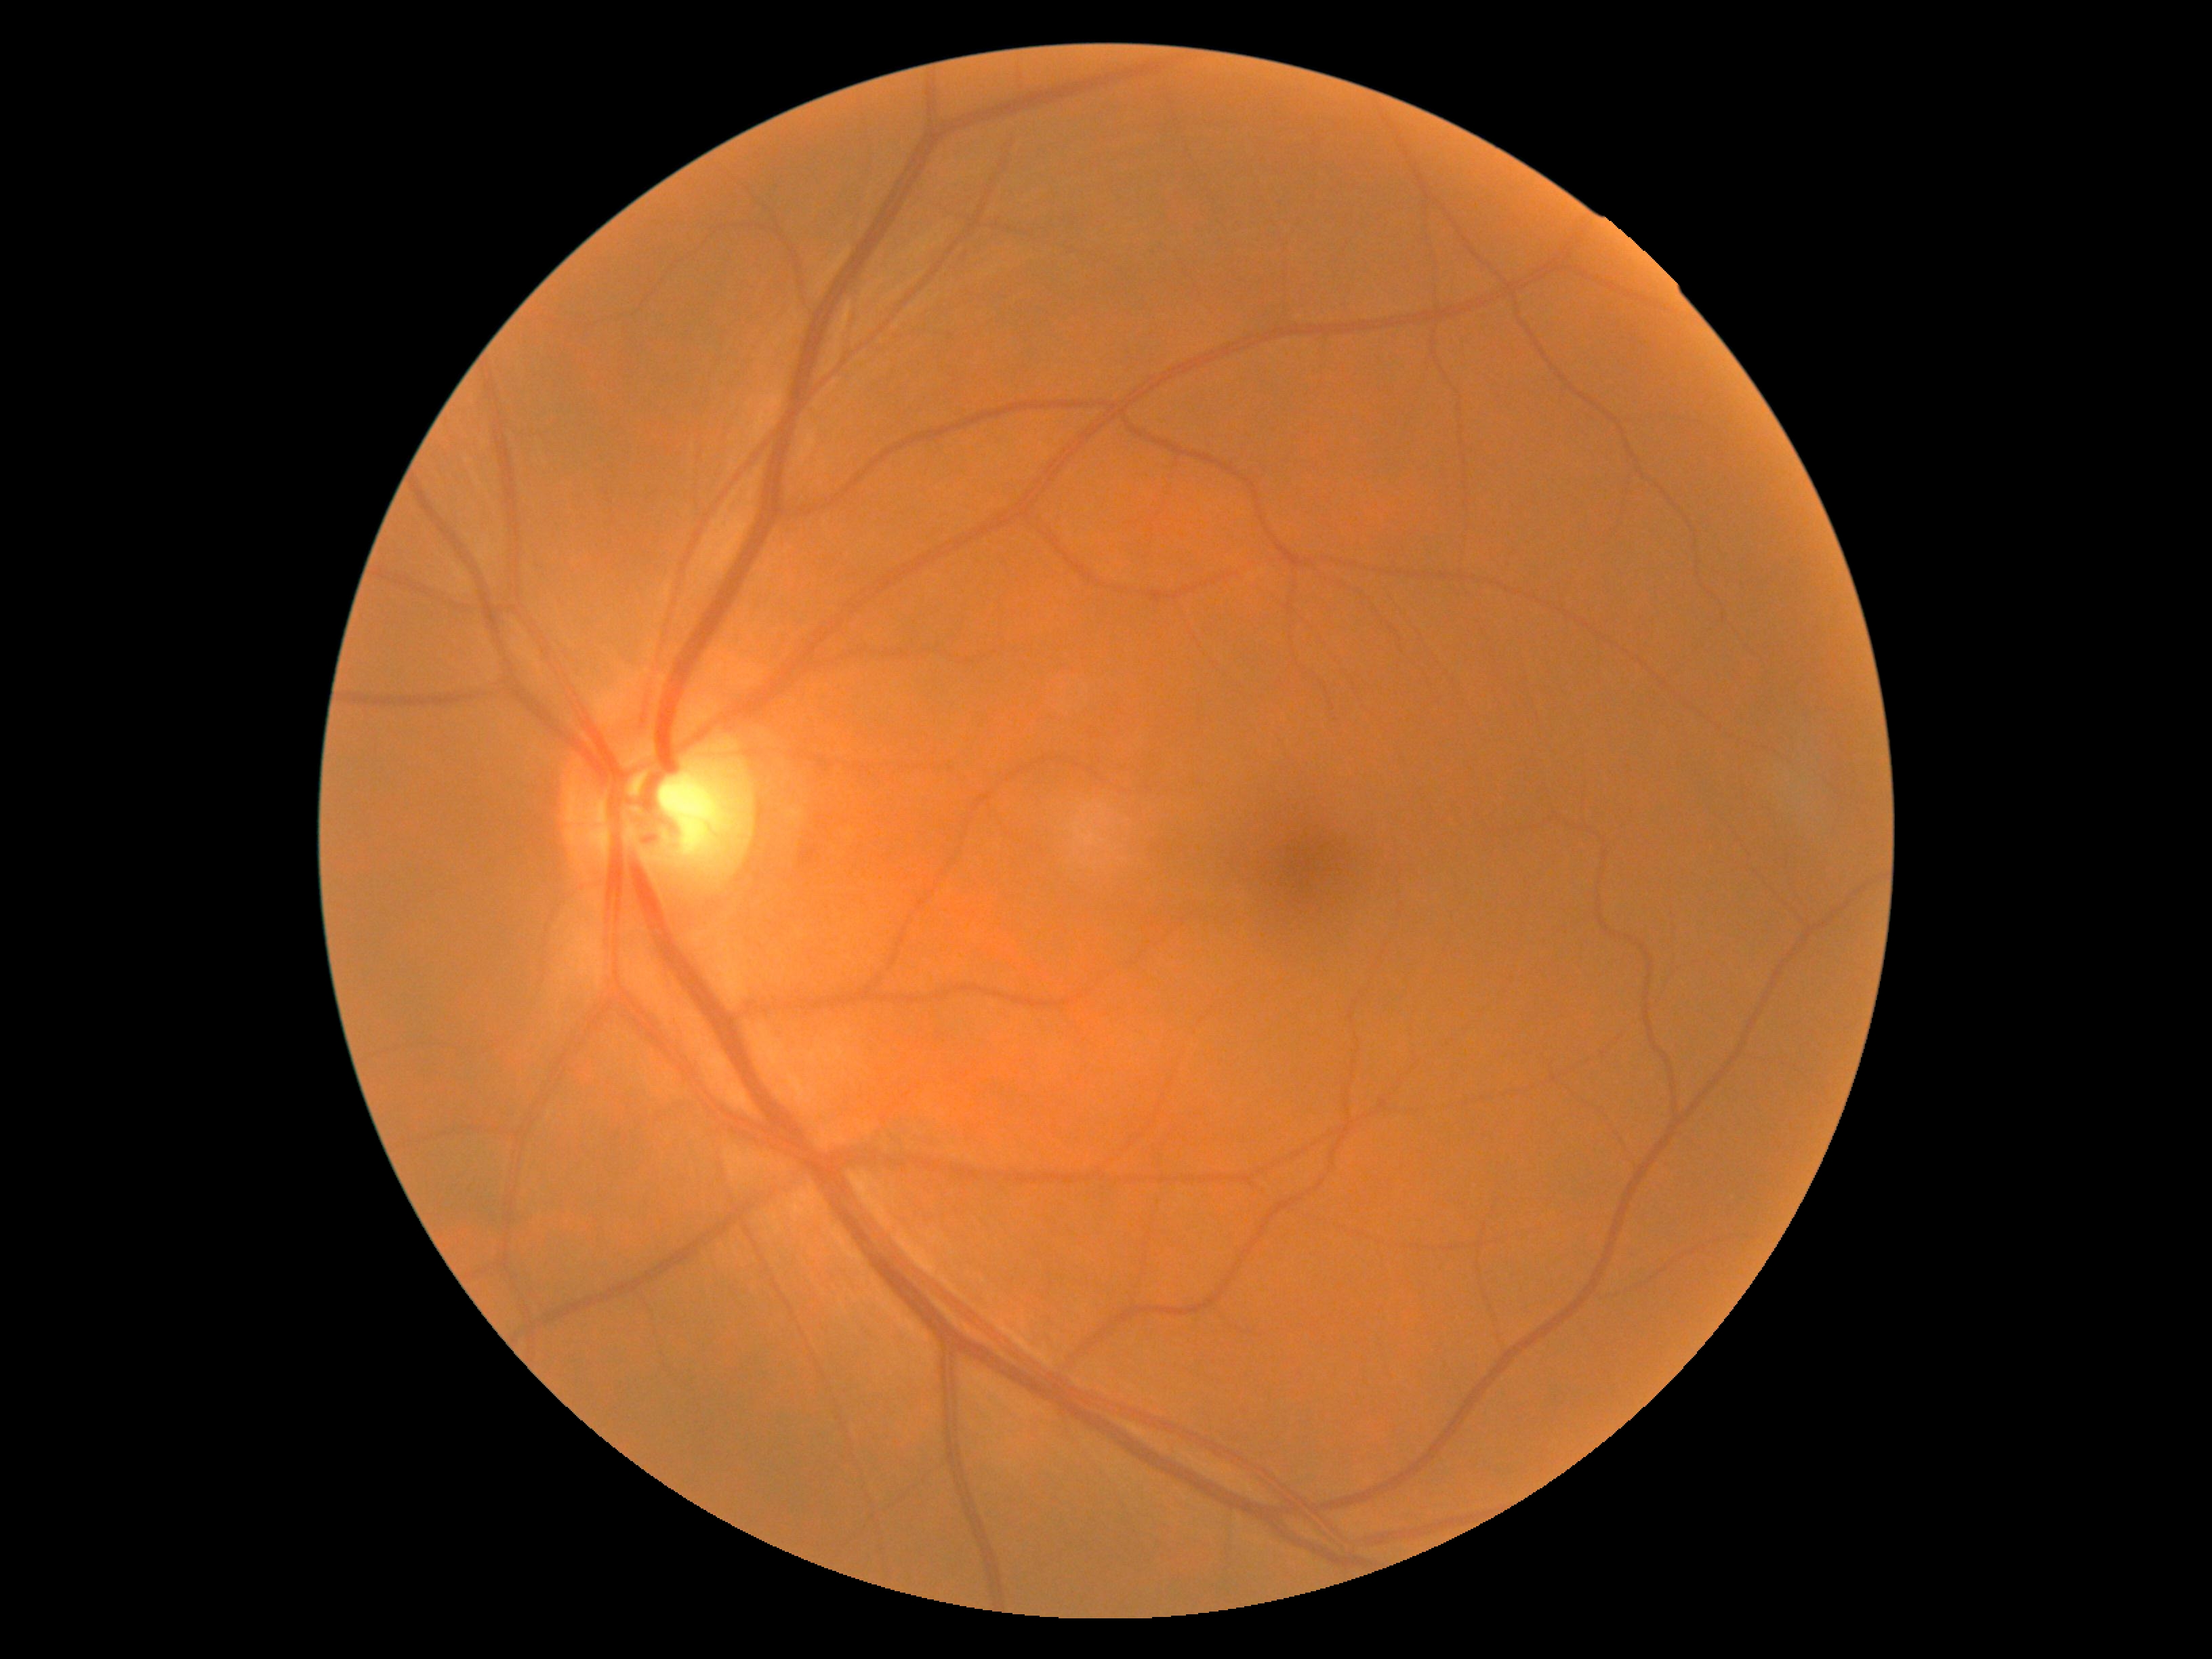 DR stage: grade 0 (no apparent retinopathy).